2184 by 1691 pixels. Fundus photo. 45° FOV
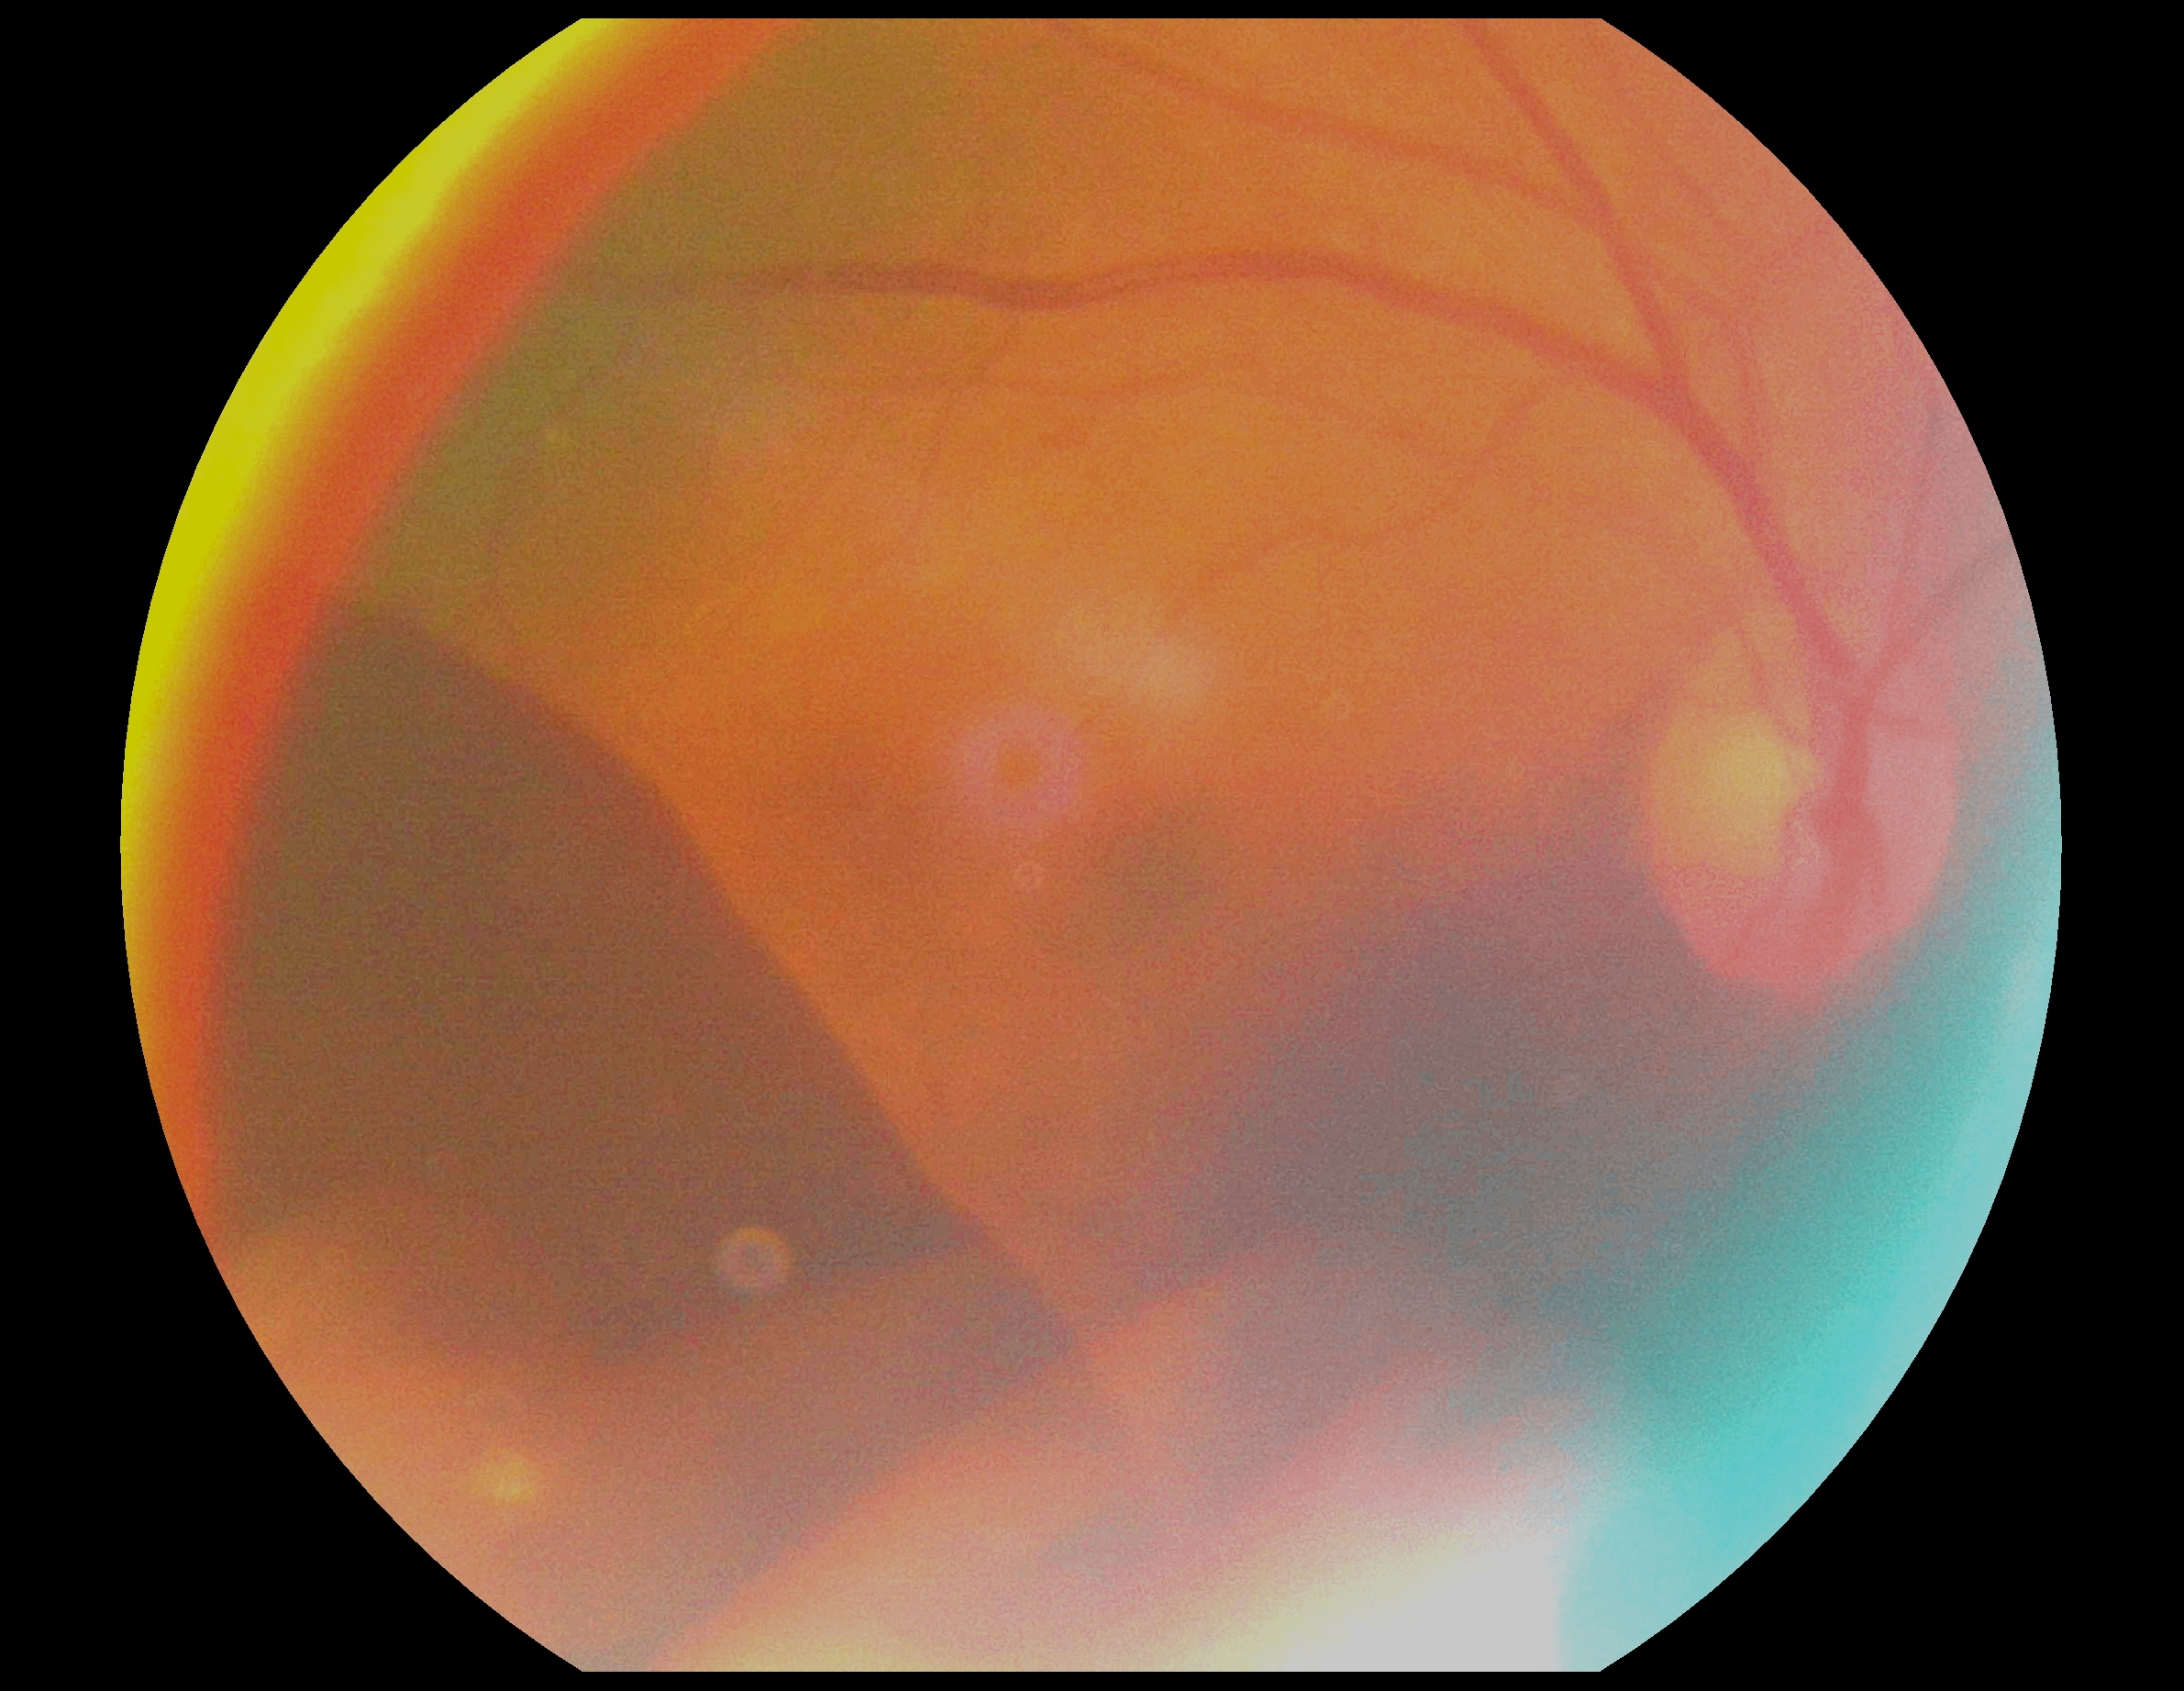
Annotations:
• DR — grade 4 (PDR)